Posterior pole color fundus photograph, NIDEK AFC-230, 45 degree fundus photograph.
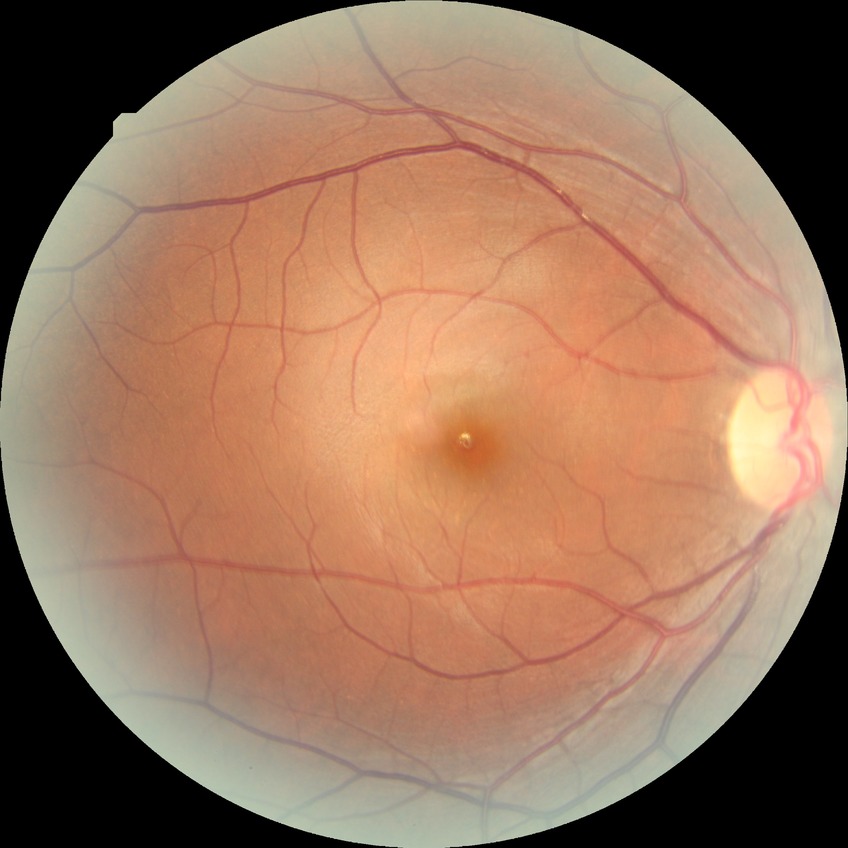

modified Davis classification@no diabetic retinopathy.